Optic disc region crop · CFP · non-mydriatic fundus camera:
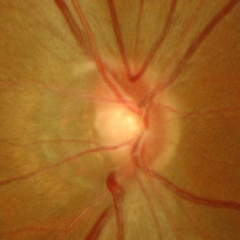 There is evidence of early glaucoma.